Modified Davis grading
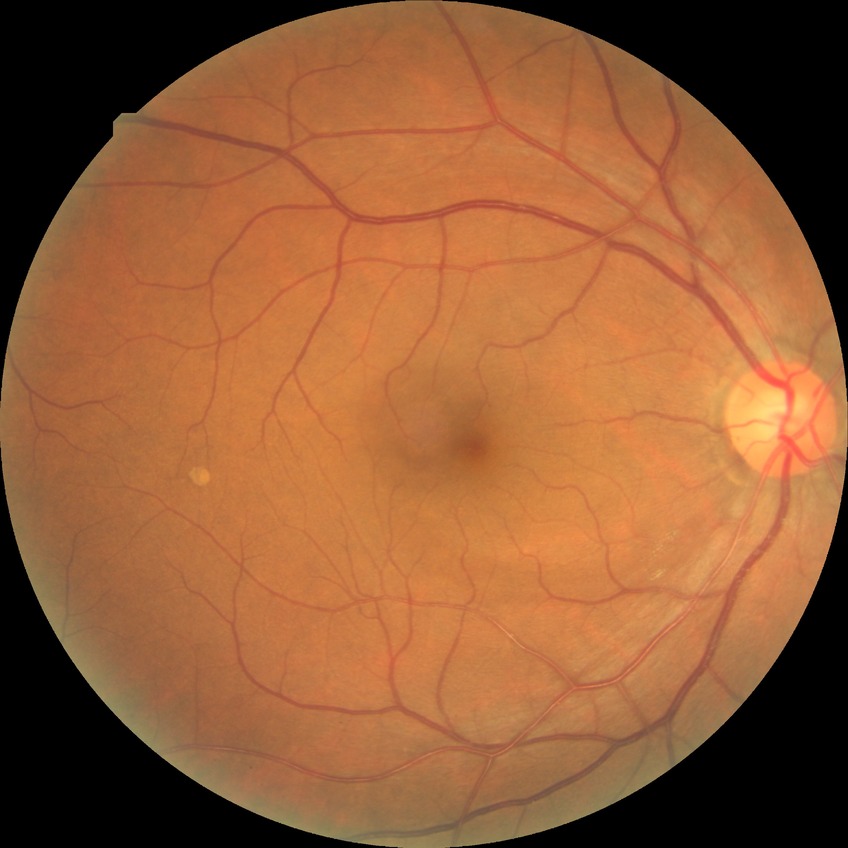

Diabetic retinopathy (DR): NDR (no diabetic retinopathy).